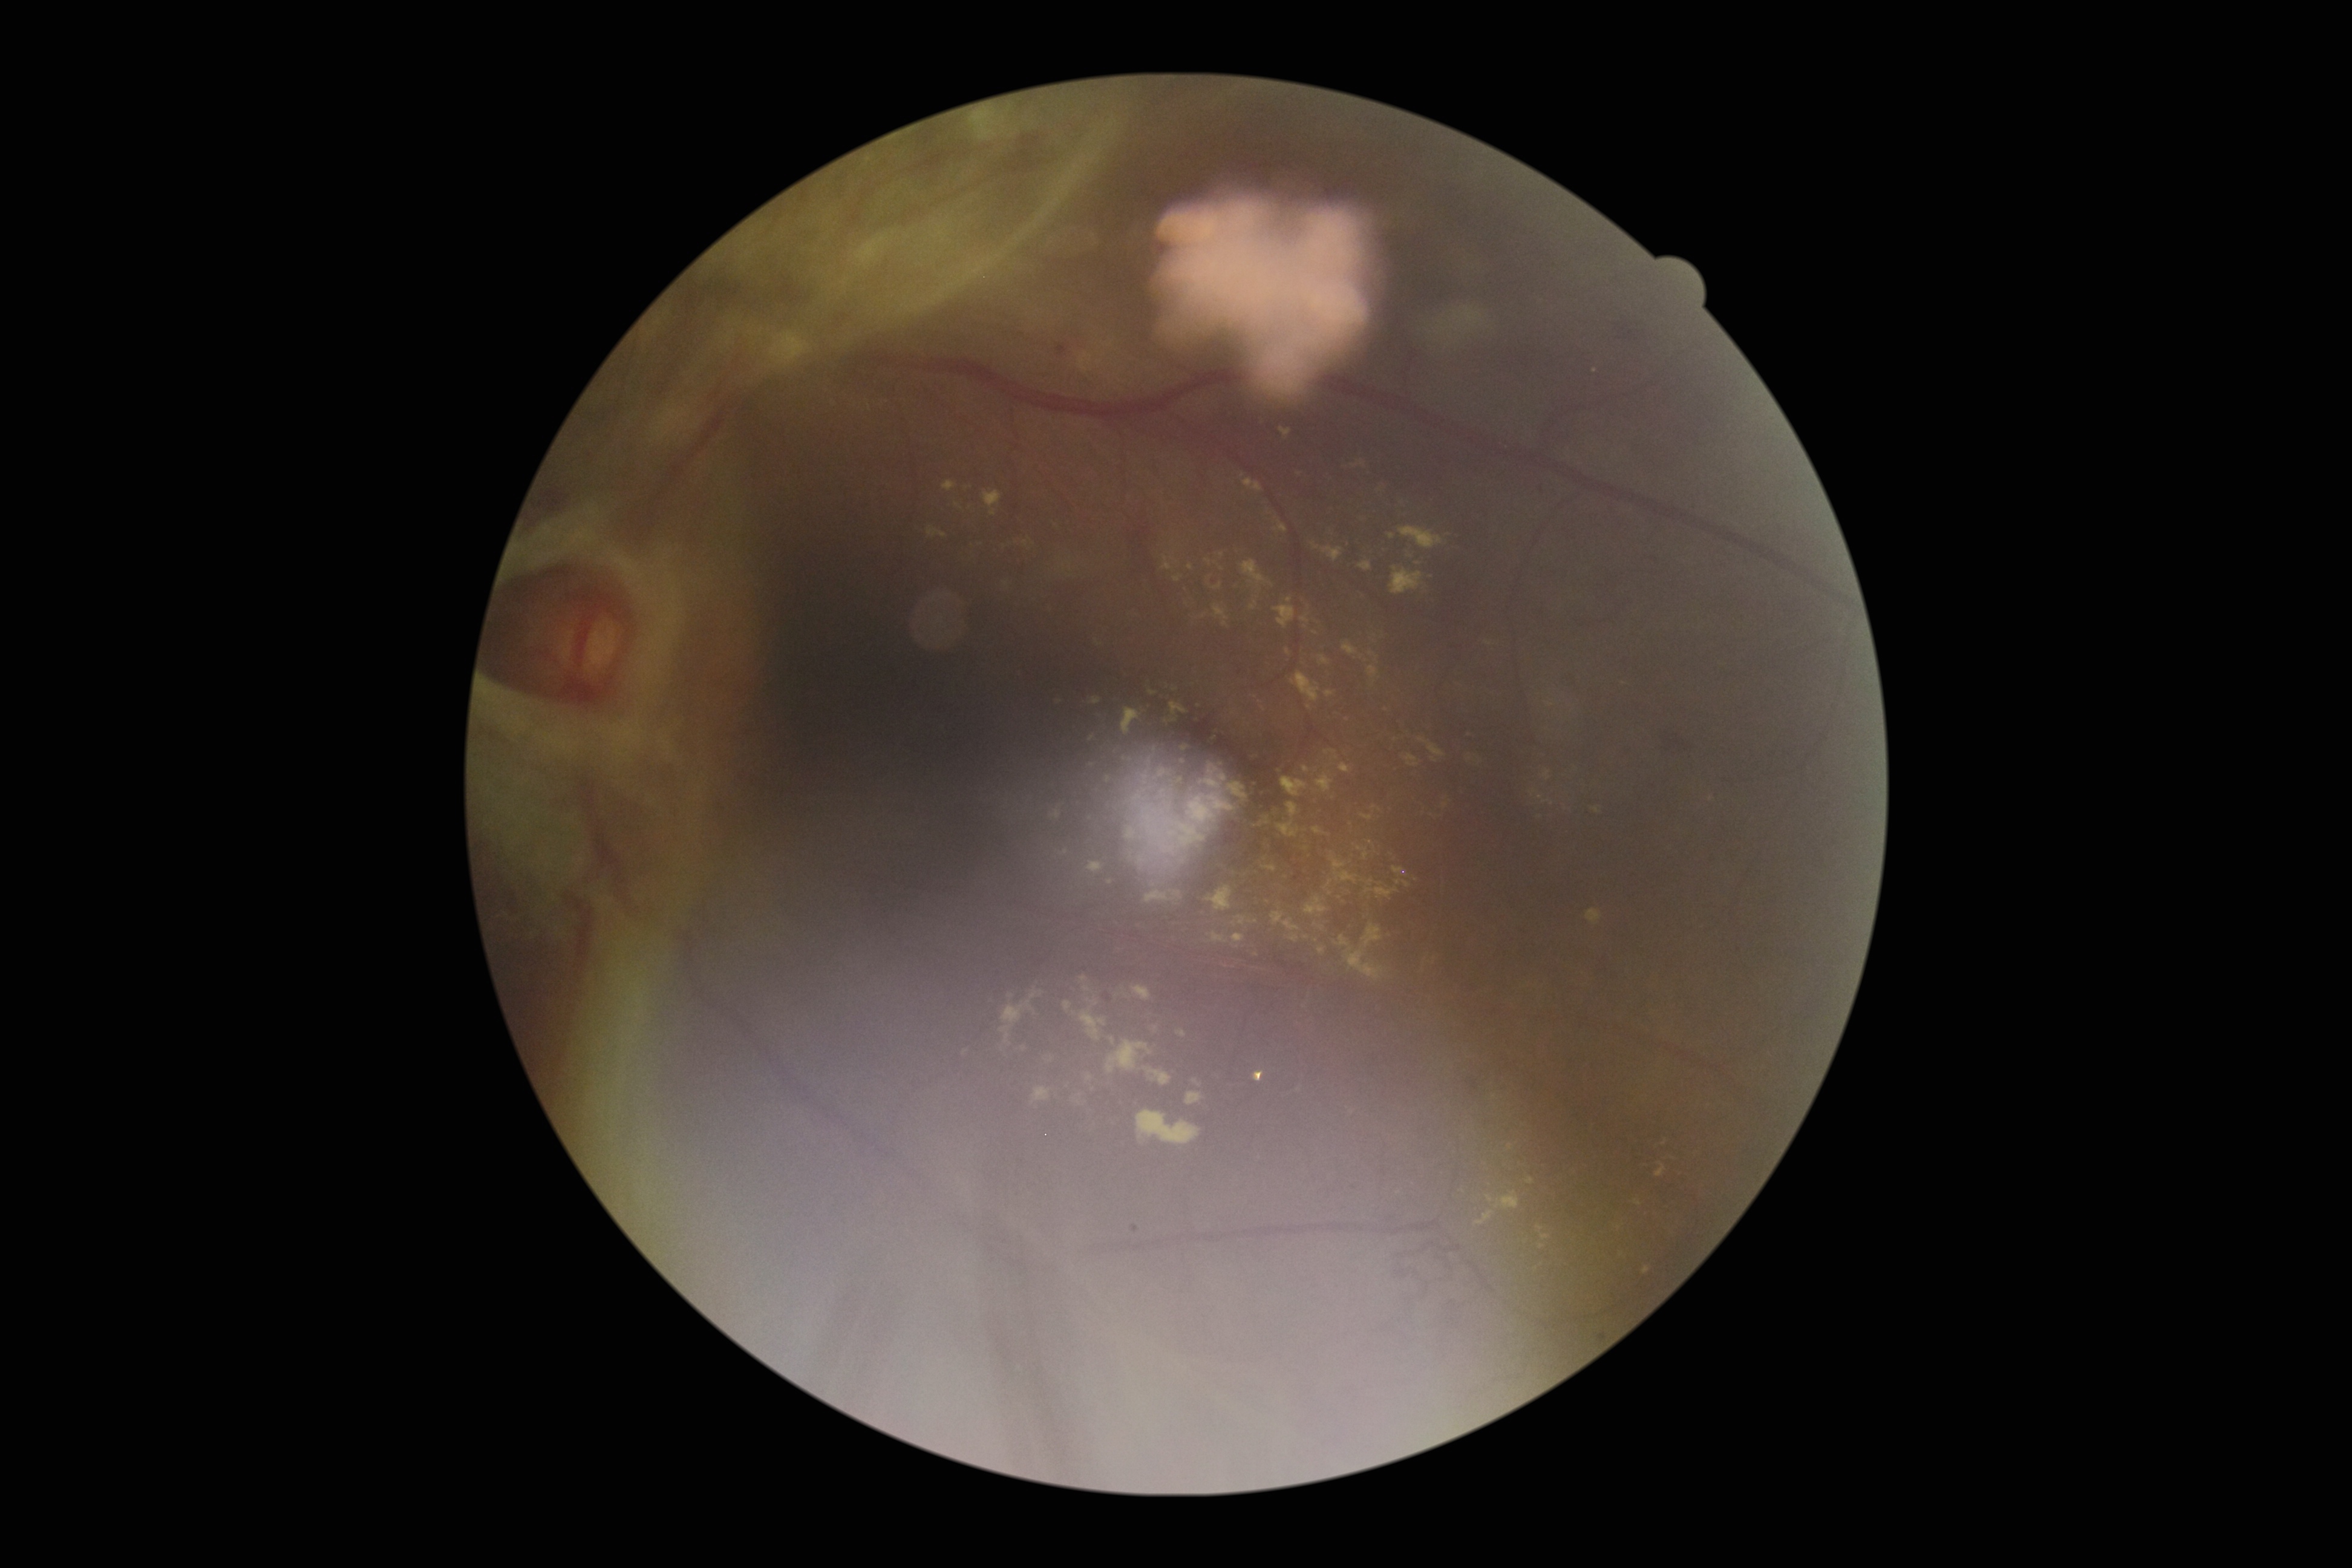 Diabetic retinopathy (DR) is grade 4
Representative lesions:
- hard exudates (EXs) (continued): 1391, 567, 1422, 595; 1149, 687, 1161, 696; 1122, 850, 1149, 872; 1041, 1057, 1054, 1069; 1313, 777, 1335, 795; 1213, 584, 1223, 591; 1311, 822, 1336, 841; 1263, 832, 1276, 854; 1085, 691, 1102, 704; 1285, 649, 1292, 658; 1270, 913, 1283, 930; 1300, 614, 1310, 625; 1135, 1108, 1204, 1149; 1214, 606, 1230, 627; 1283, 925, 1293, 939
- EXs (small, approximate centers) near (1712, 800); (1300, 474); (1222, 570)